Color fundus image; 45° field of view; 2352x1568px — 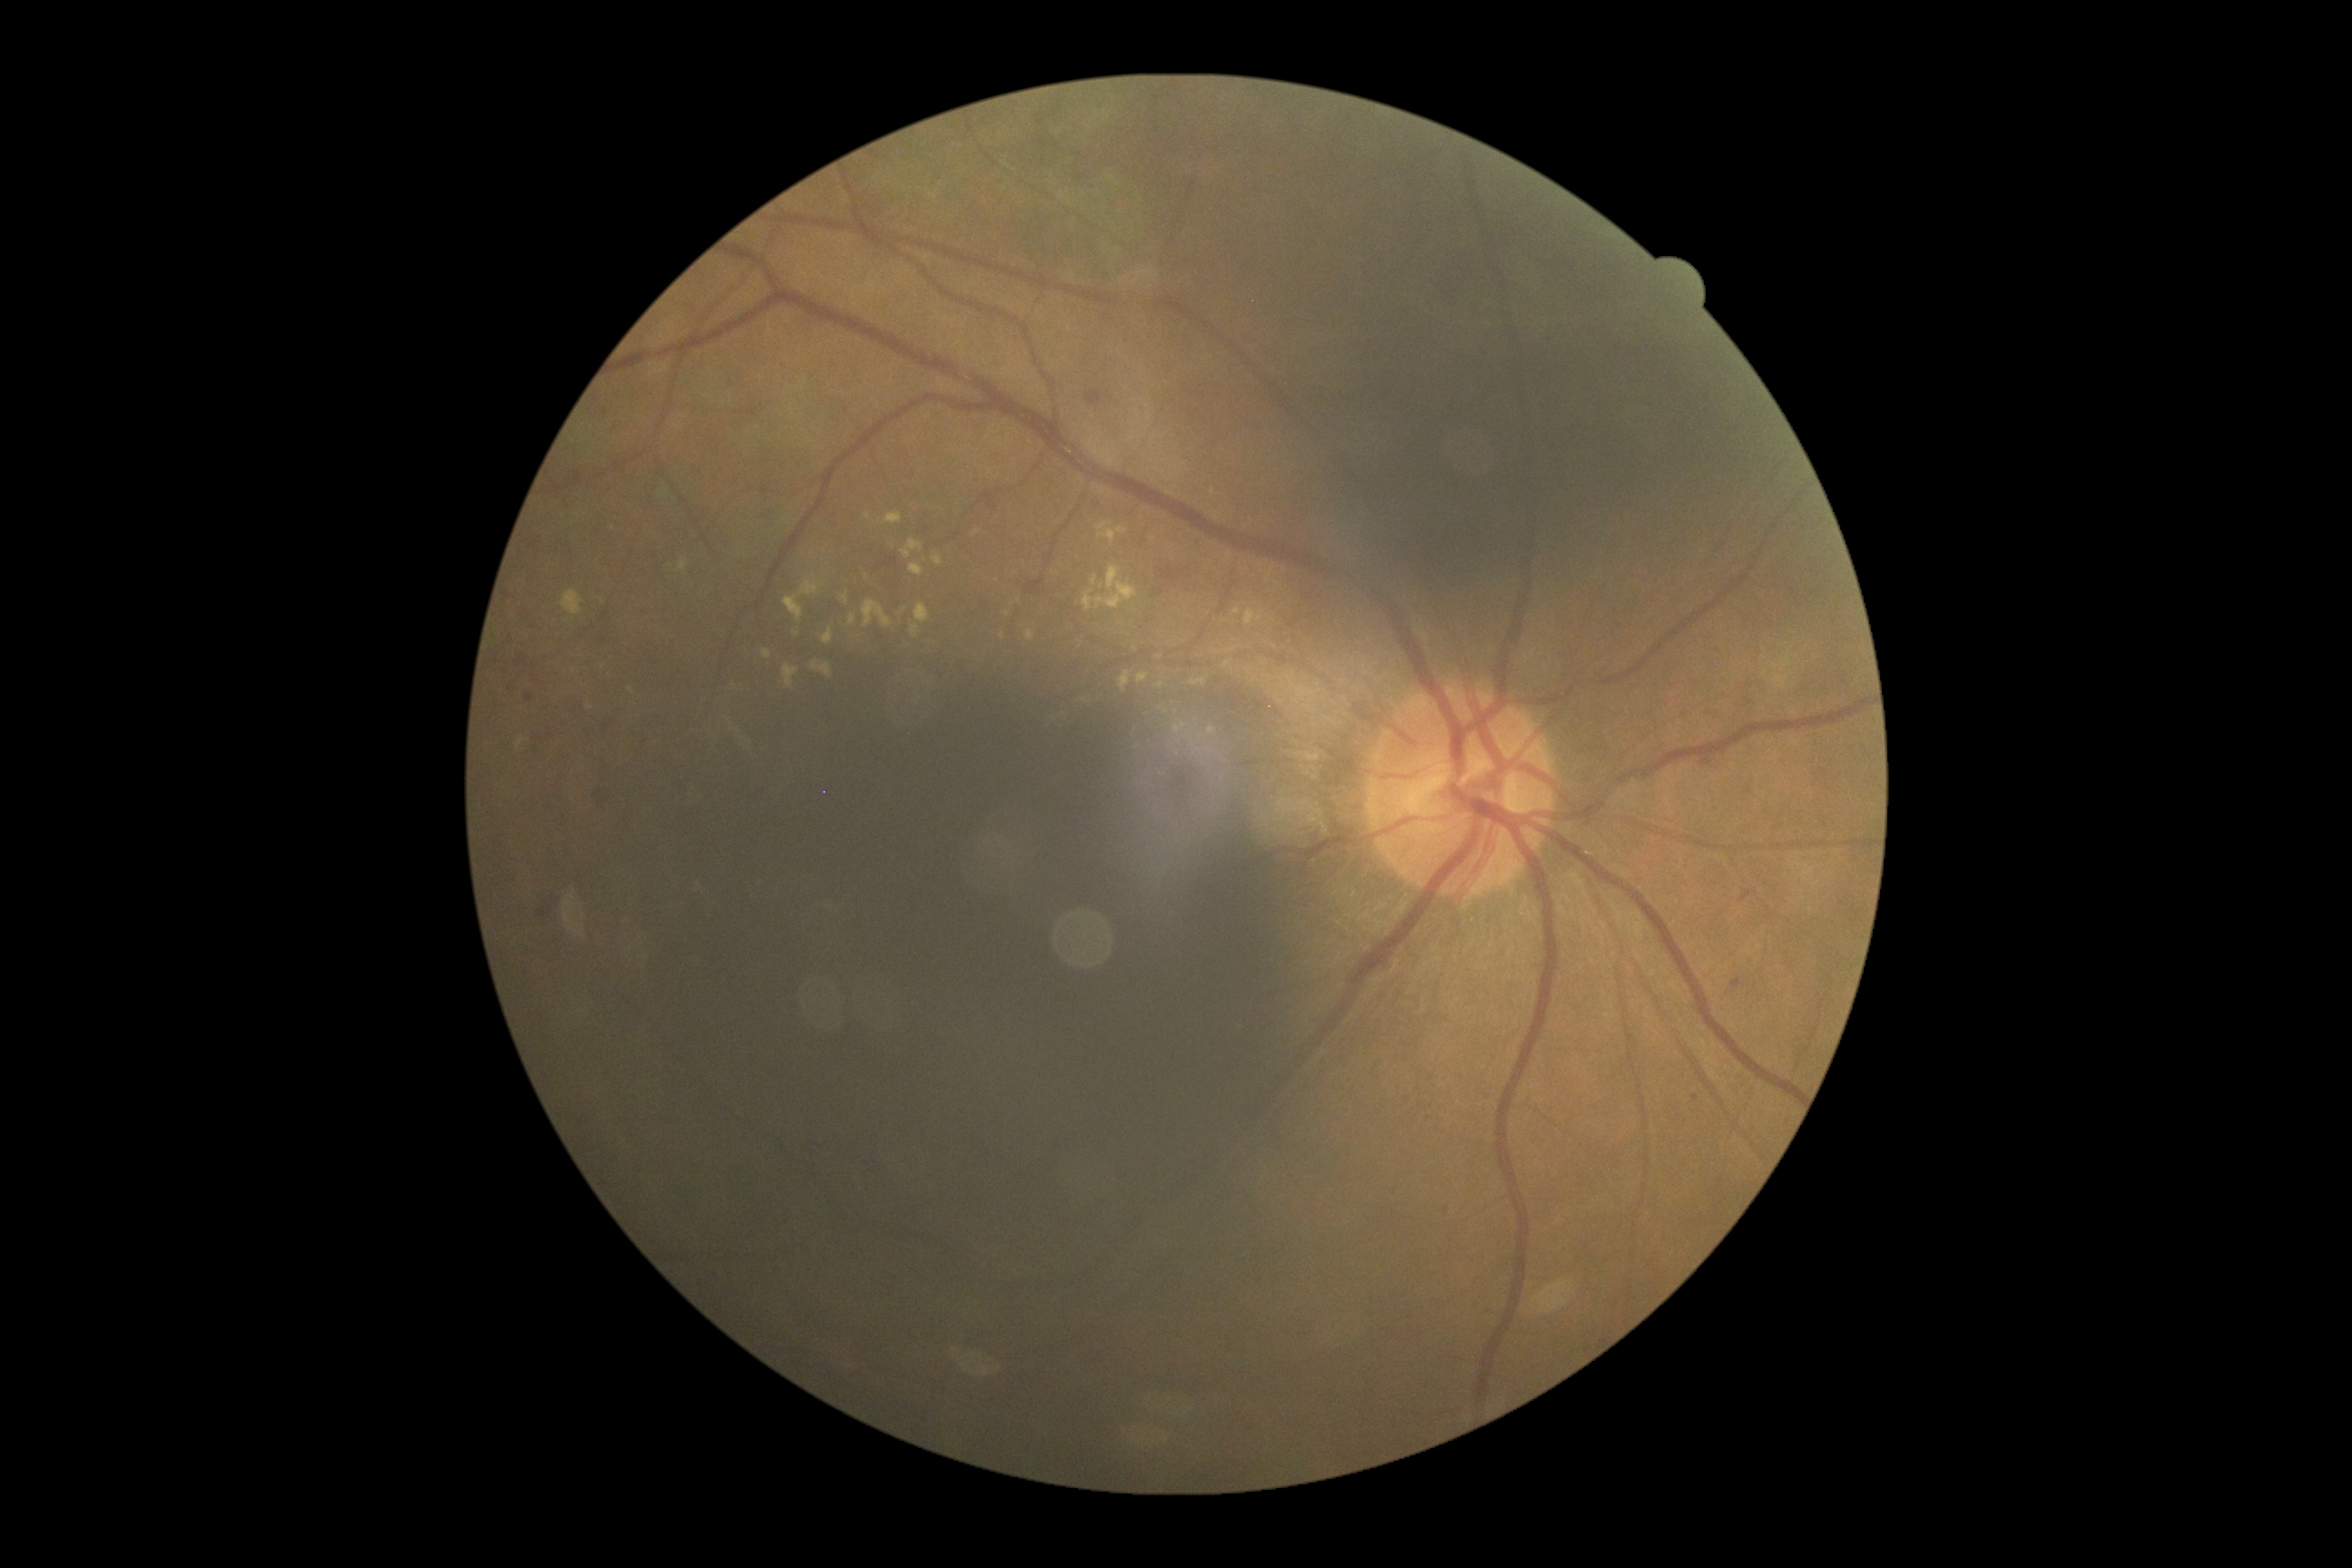

– DR grade — moderate non-proliferative diabetic retinopathy (2)
– DR class — non-proliferative diabetic retinopathy